1440x1080px; wide-field fundus photograph of an infant; 130° field of view (Natus RetCam Envision)
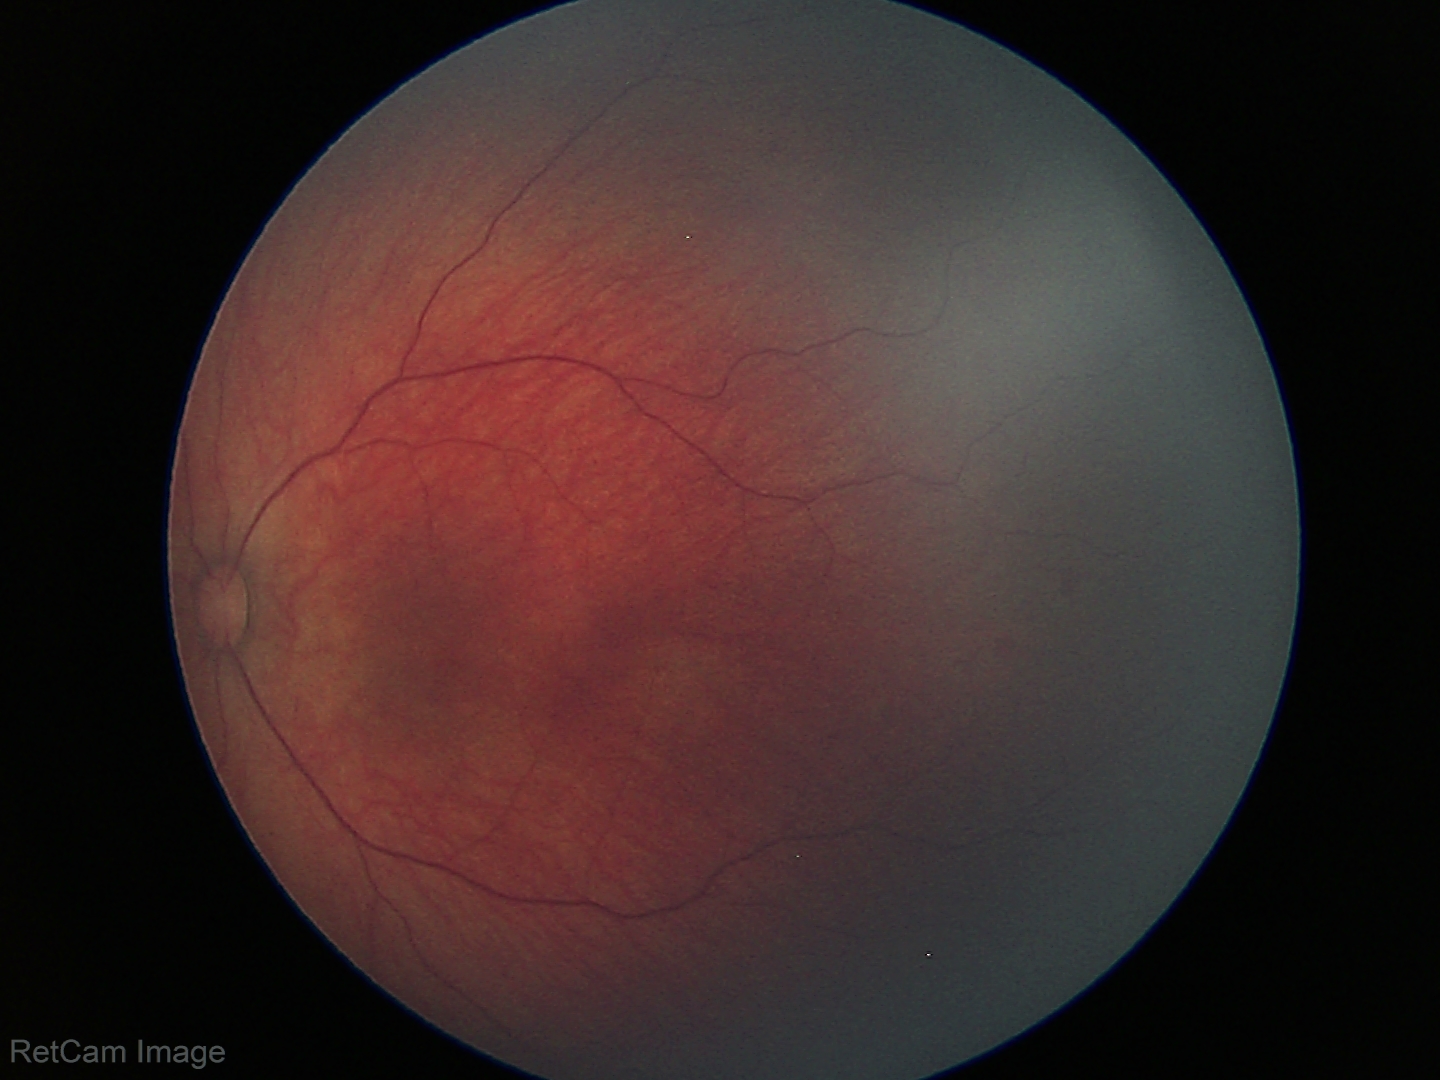
Series diagnosed as retinal hemorrhages.